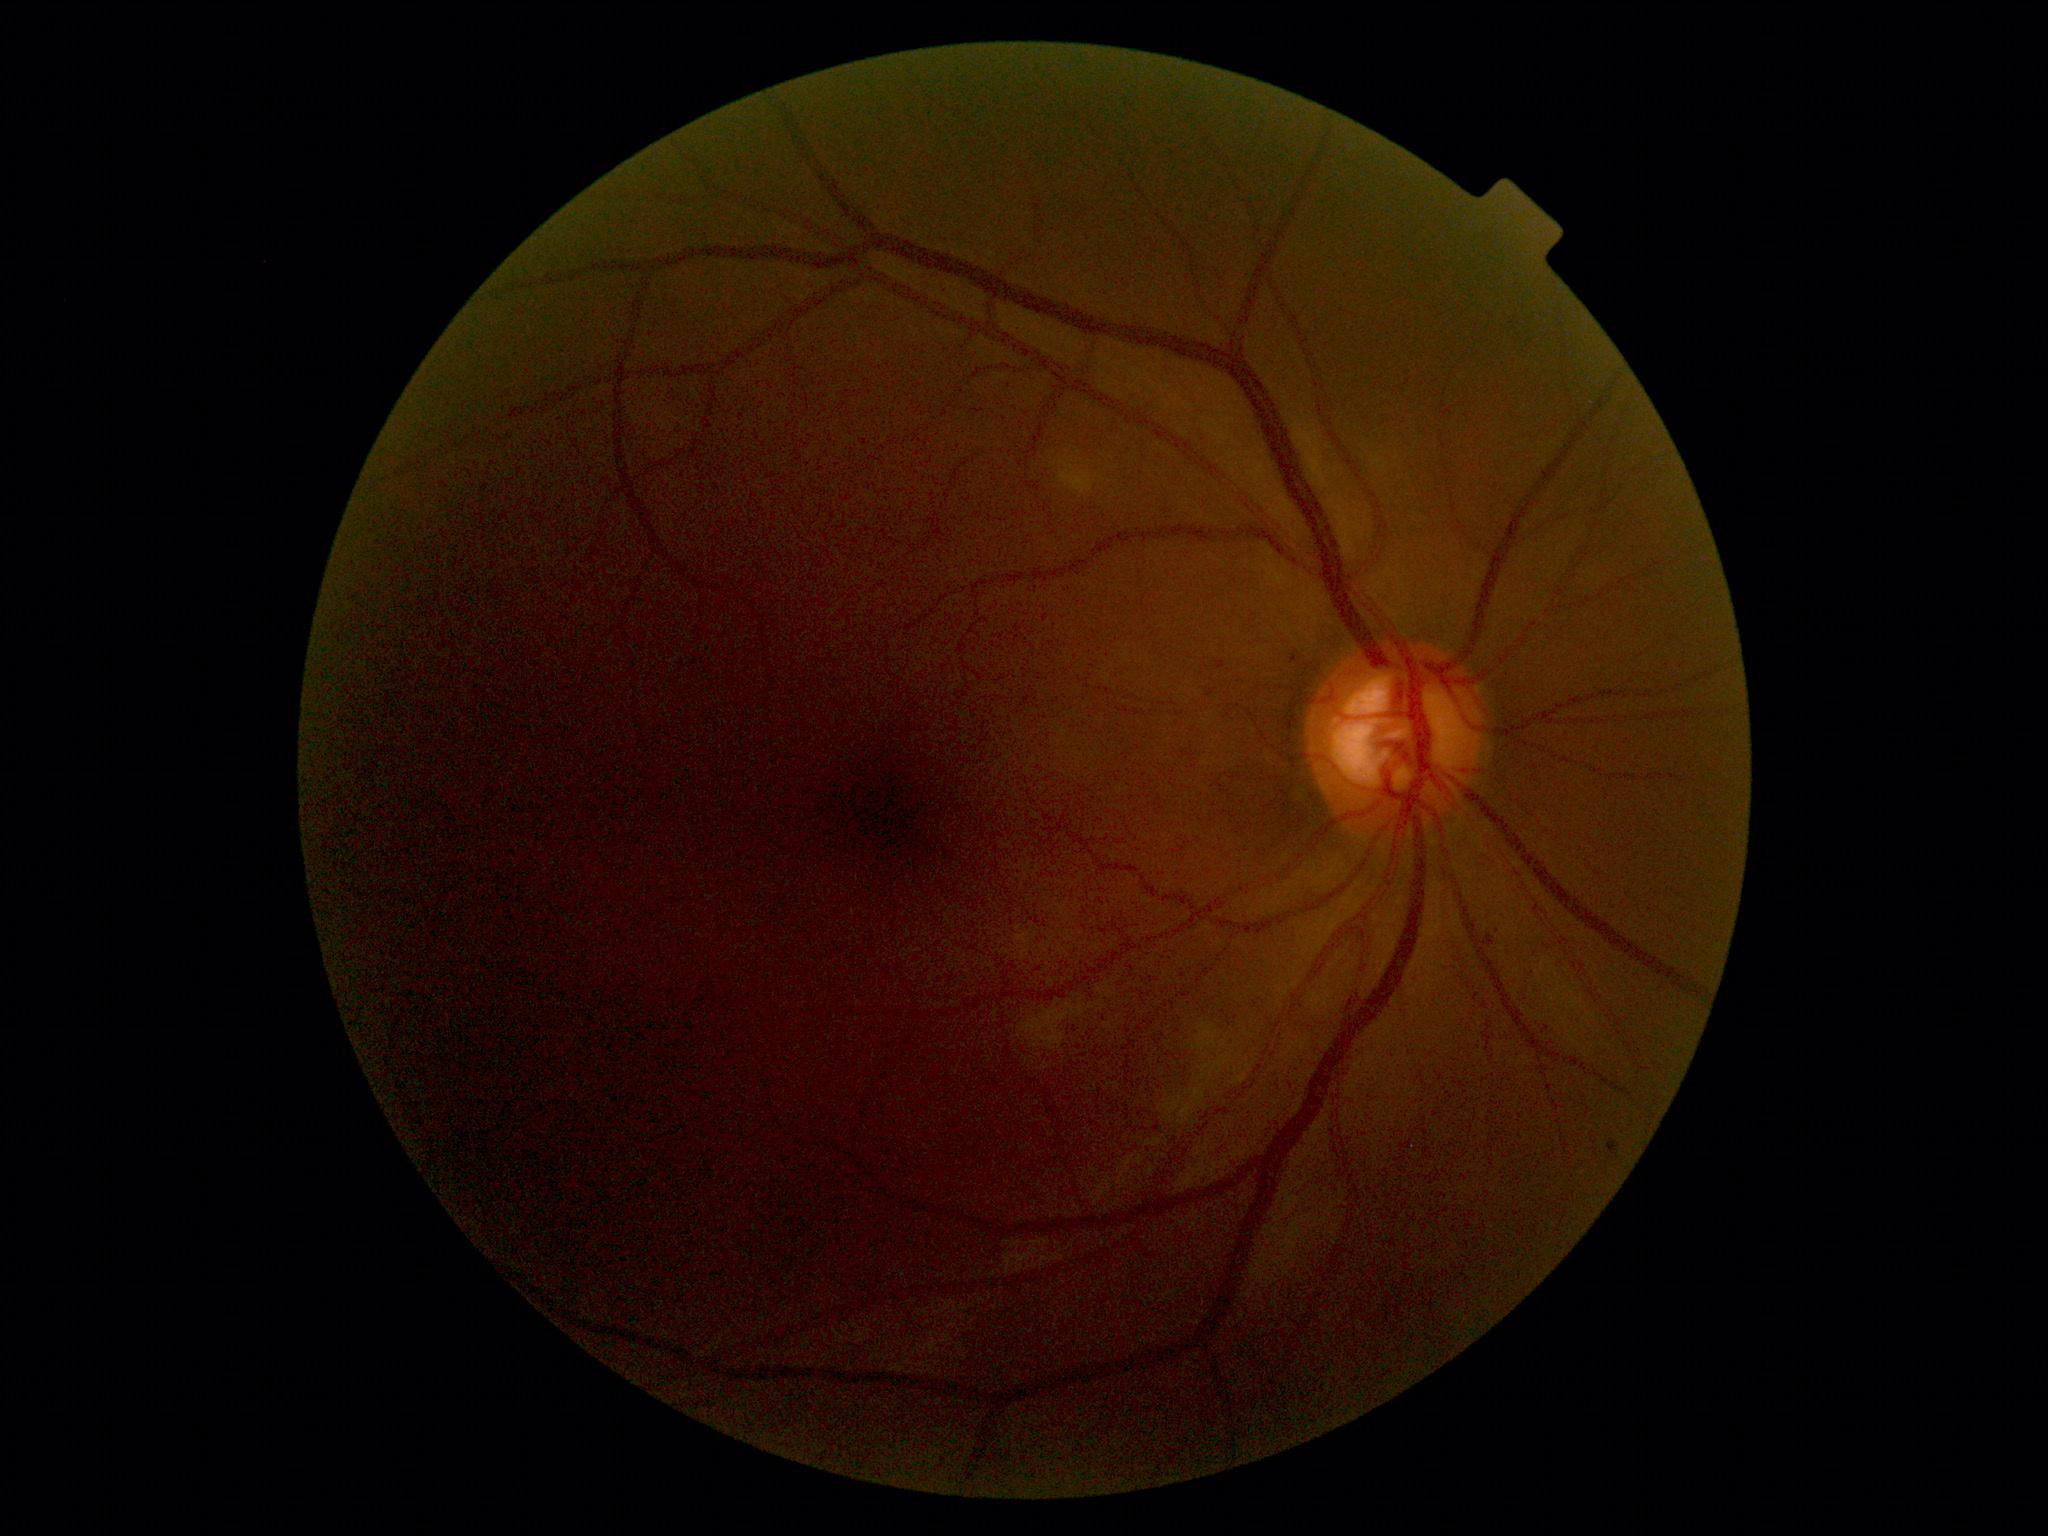

Annotations:
• retinopathy grade: moderate non-proliferative diabetic retinopathy (2)